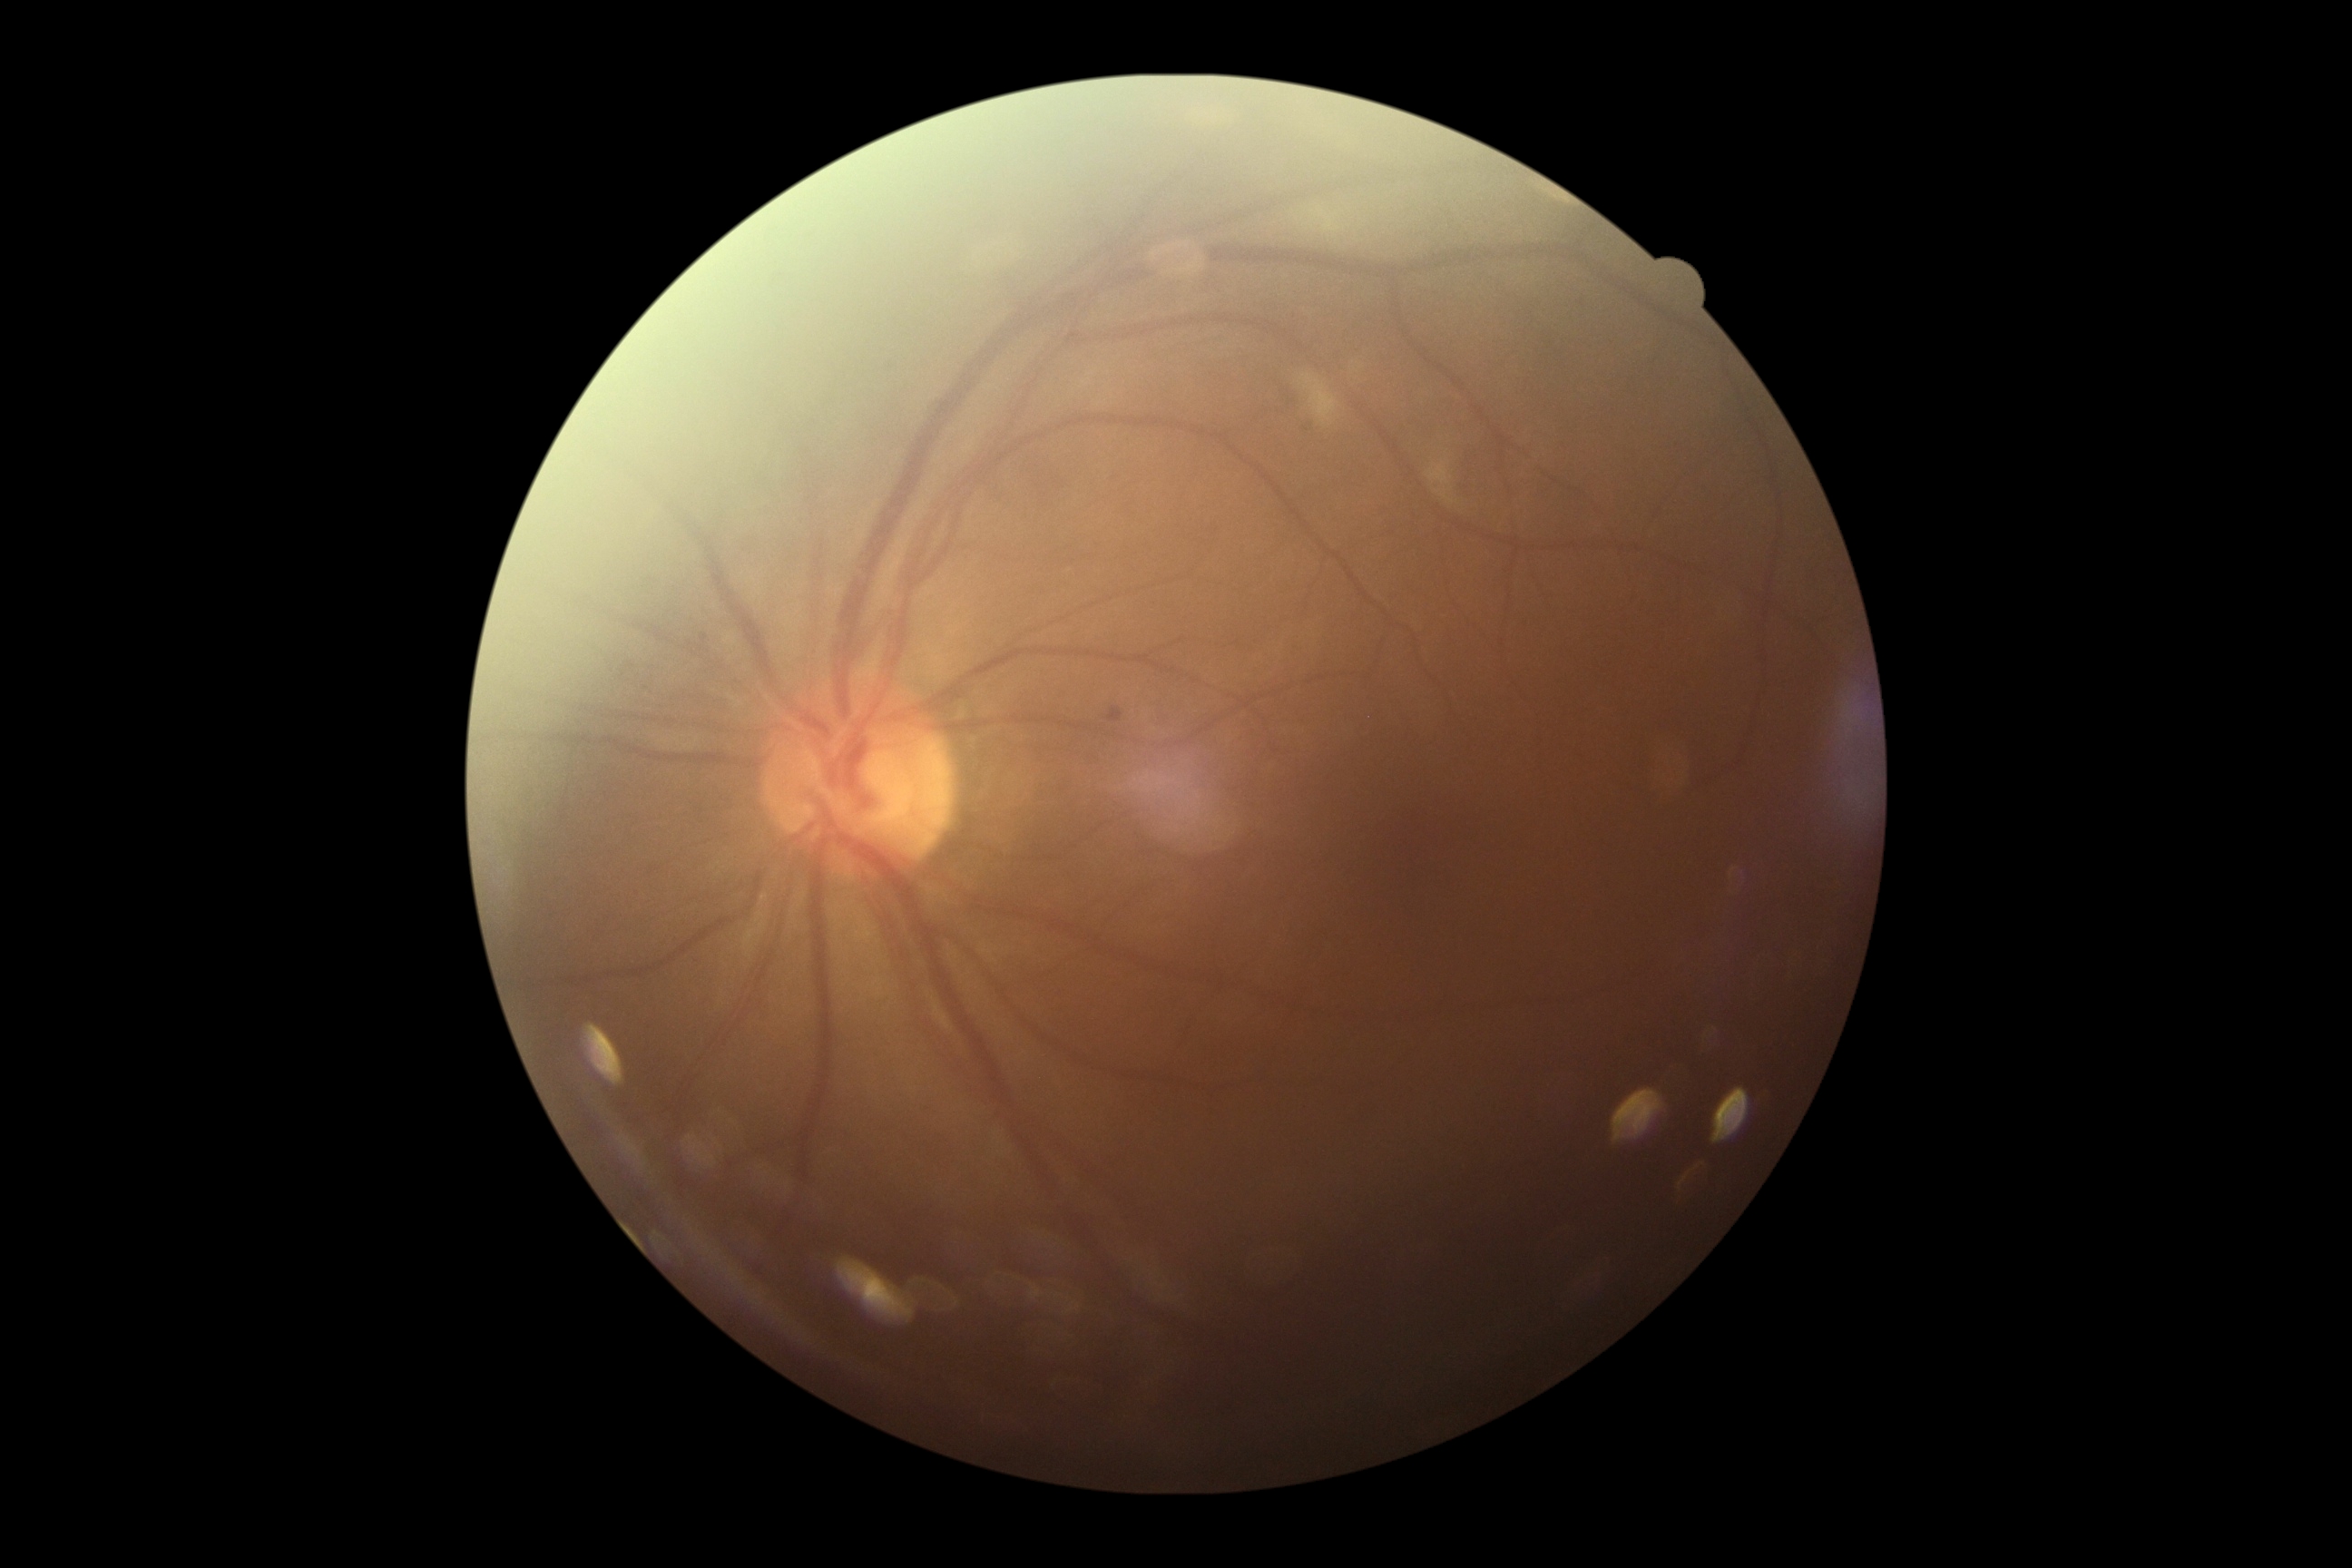

Diabetic retinopathy severity: moderate NPDR (grade 2) — more than just microaneurysms but less than severe NPDR.